Color fundus photograph from a handheld portable camera, 2212 x 1659 pixels — 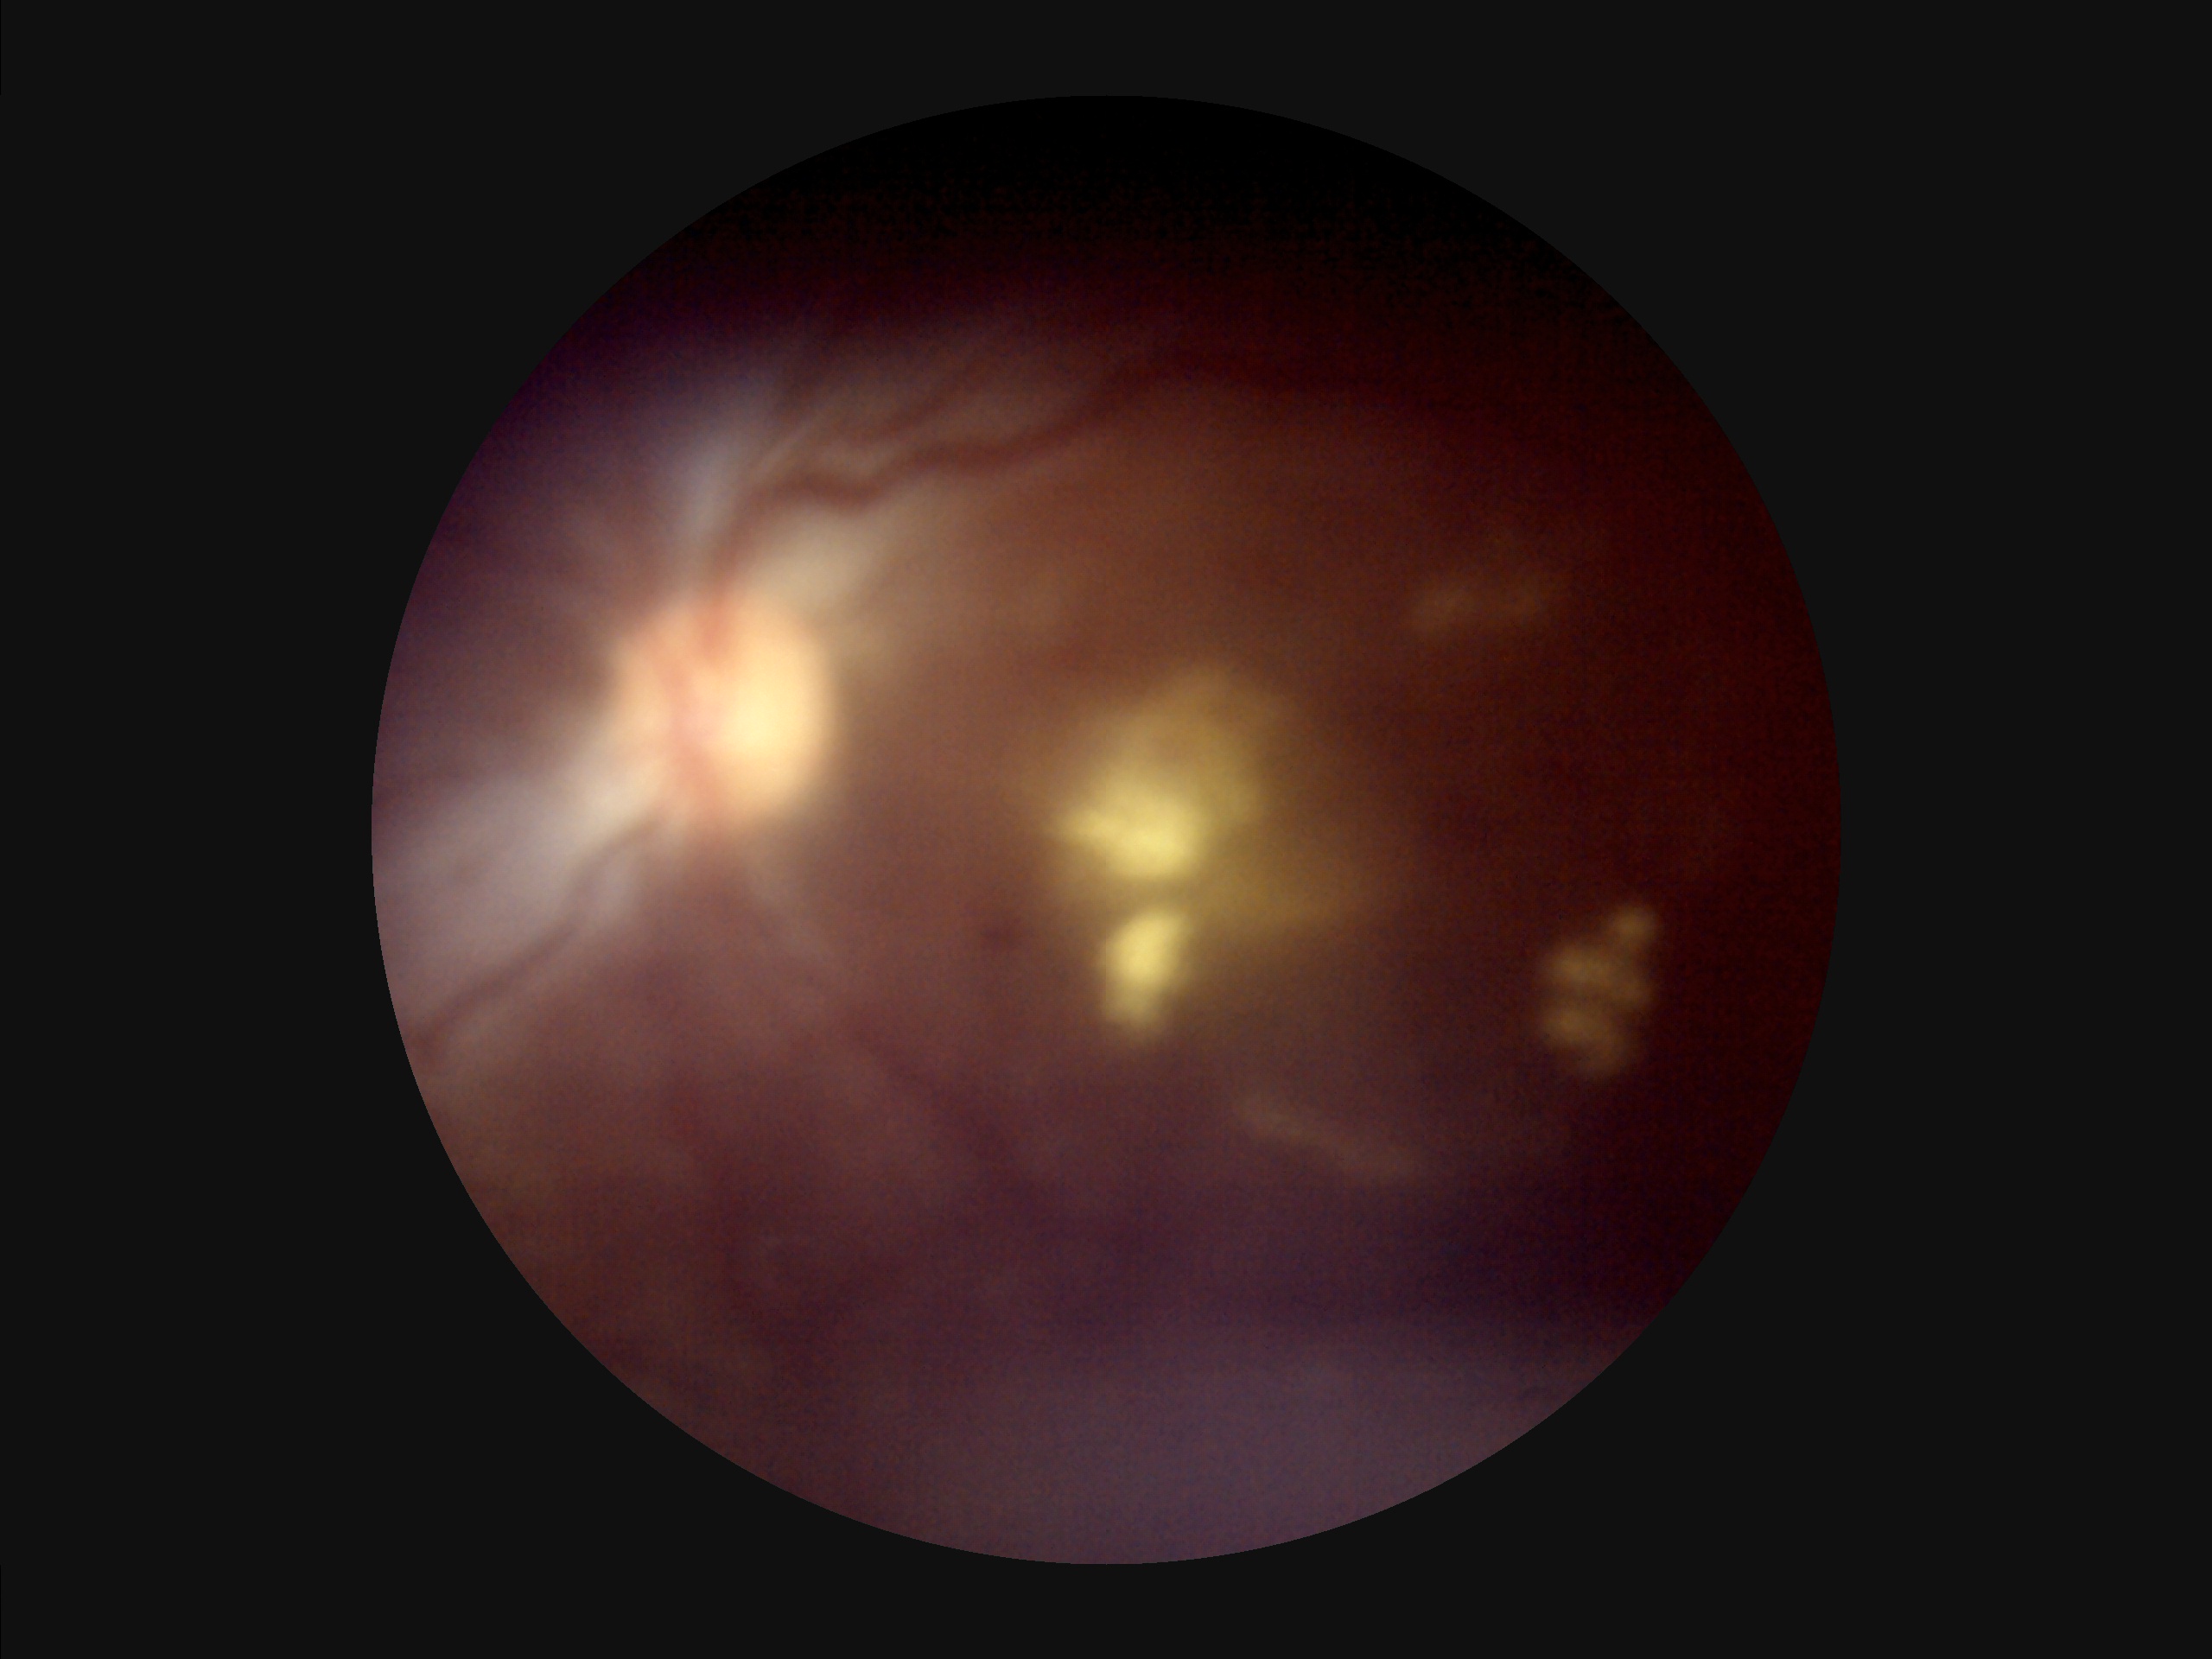
Reduced sharpness with visible blur.
Overall quality is poor; the image is difficult to grade.
Vessels and details are hard to distinguish.
Illumination and color are suboptimal.